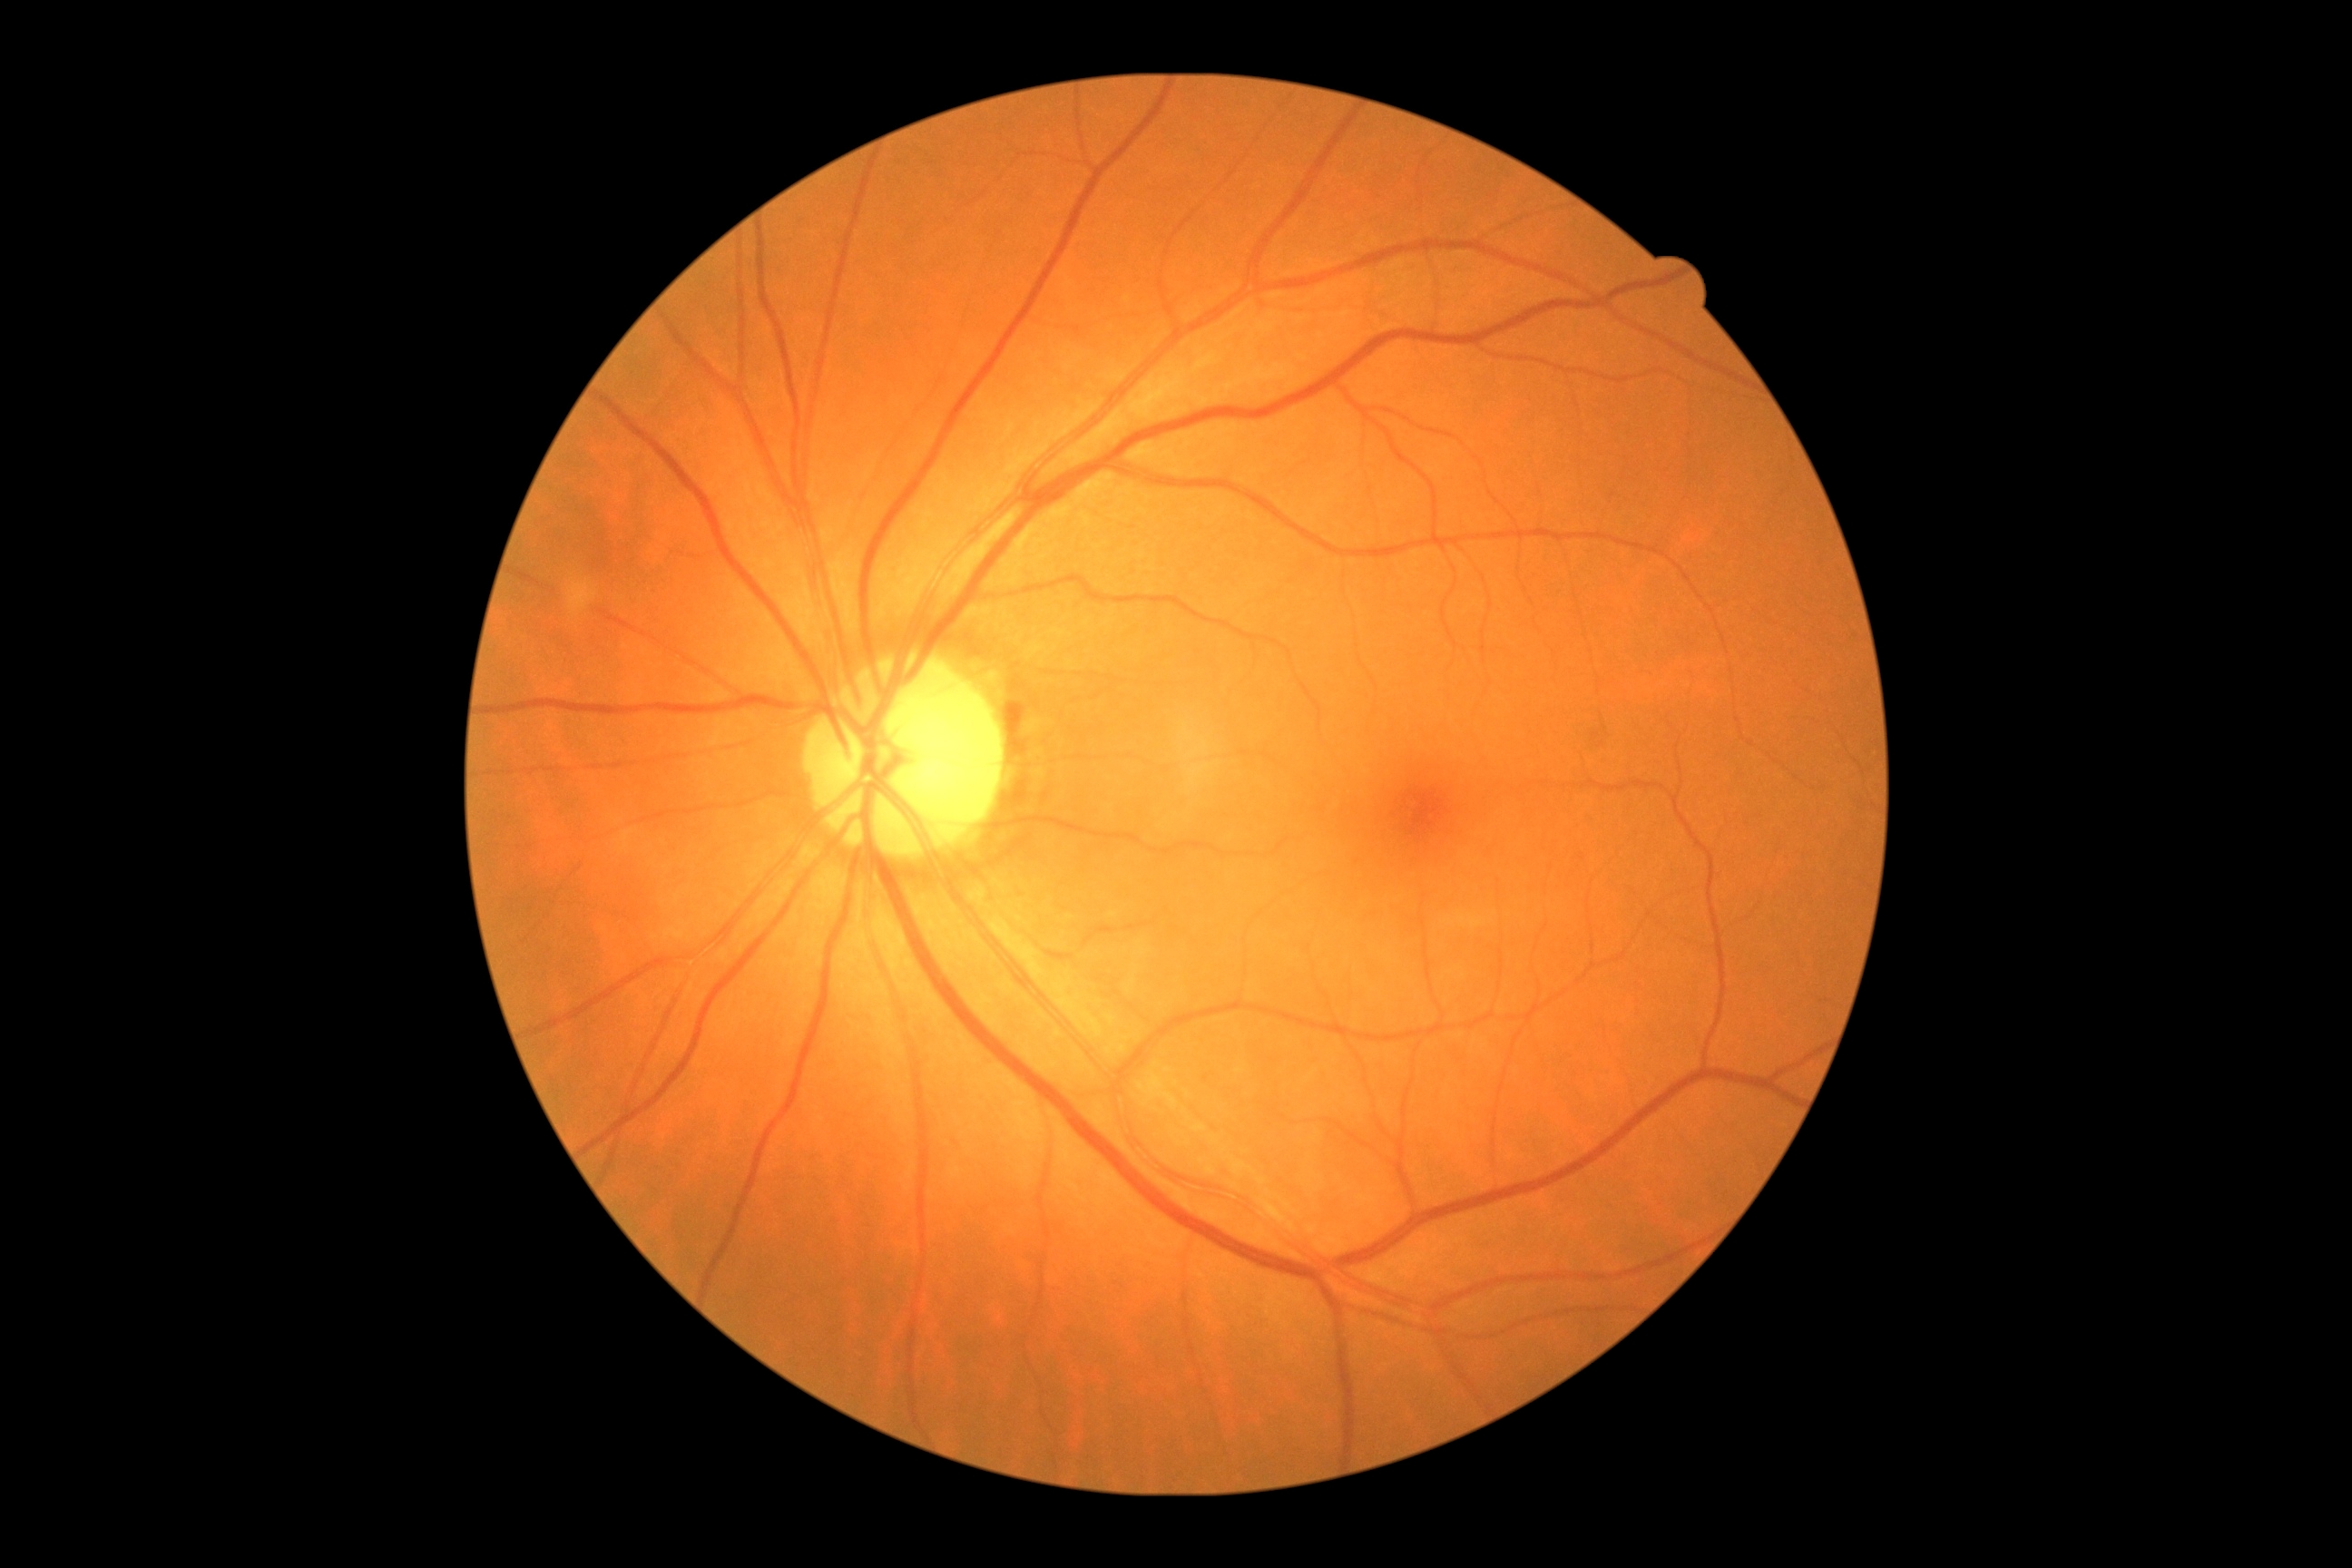 DR: 0/4.